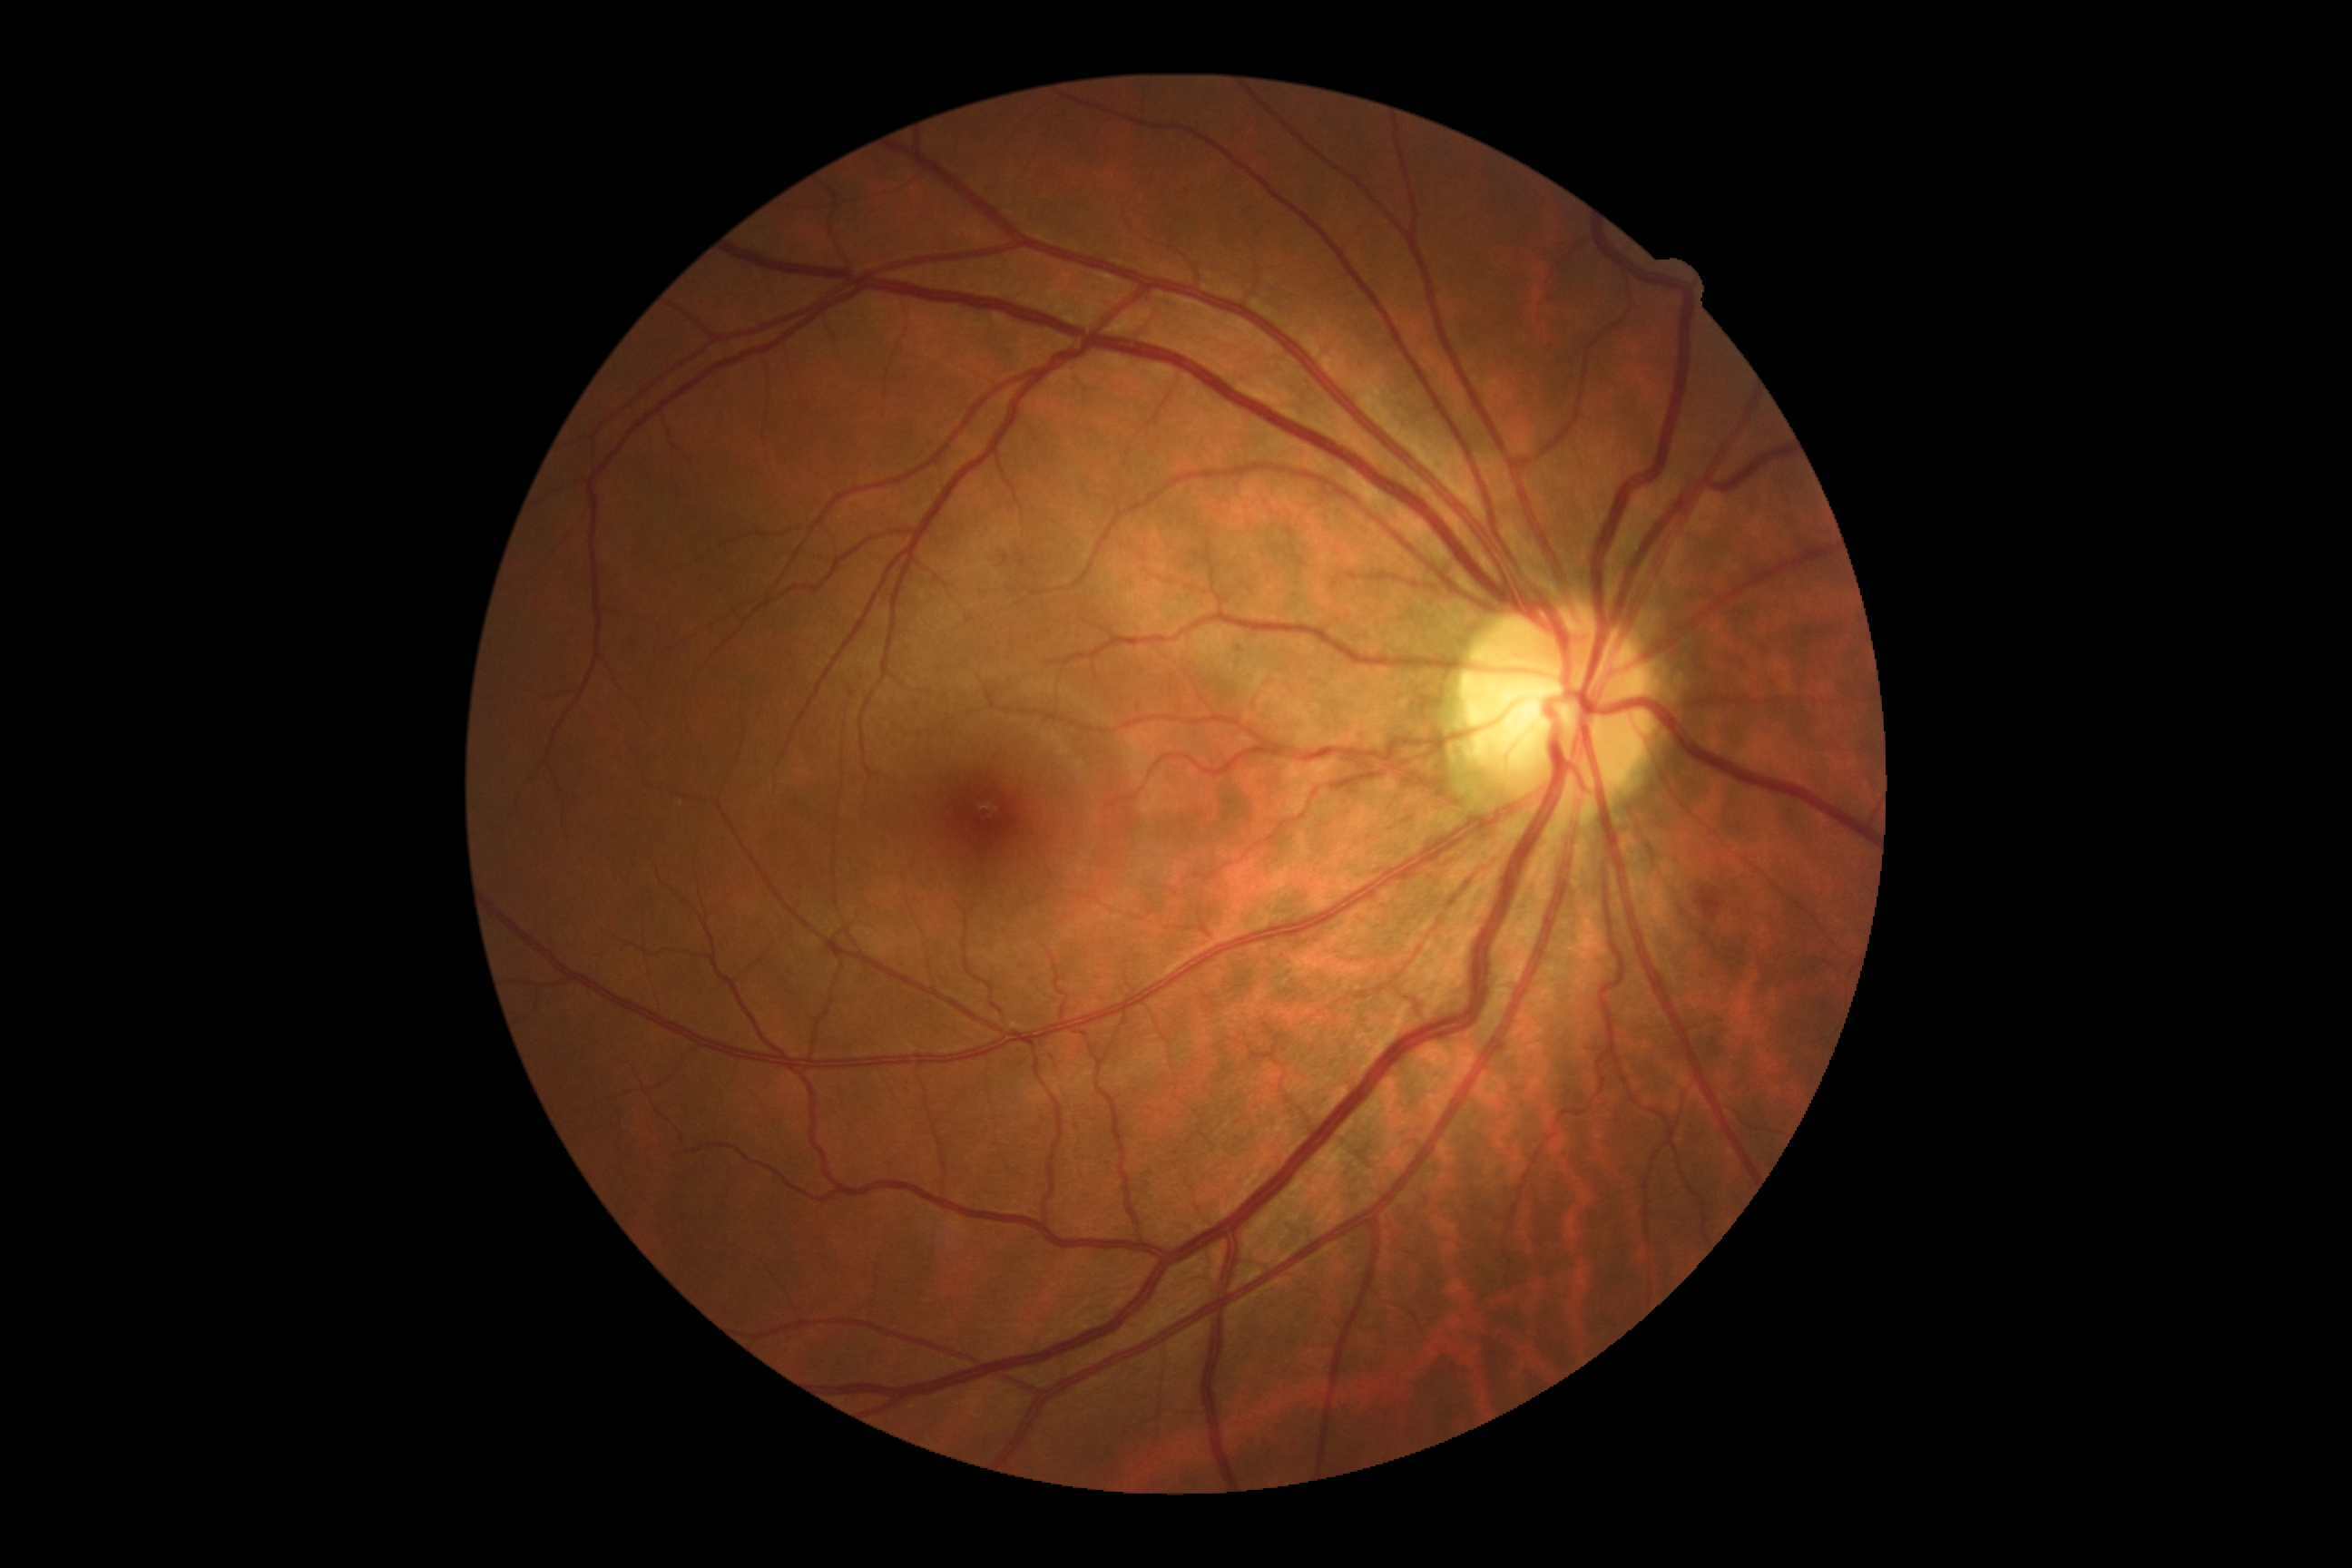
• DR: moderate NPDR (grade 2)